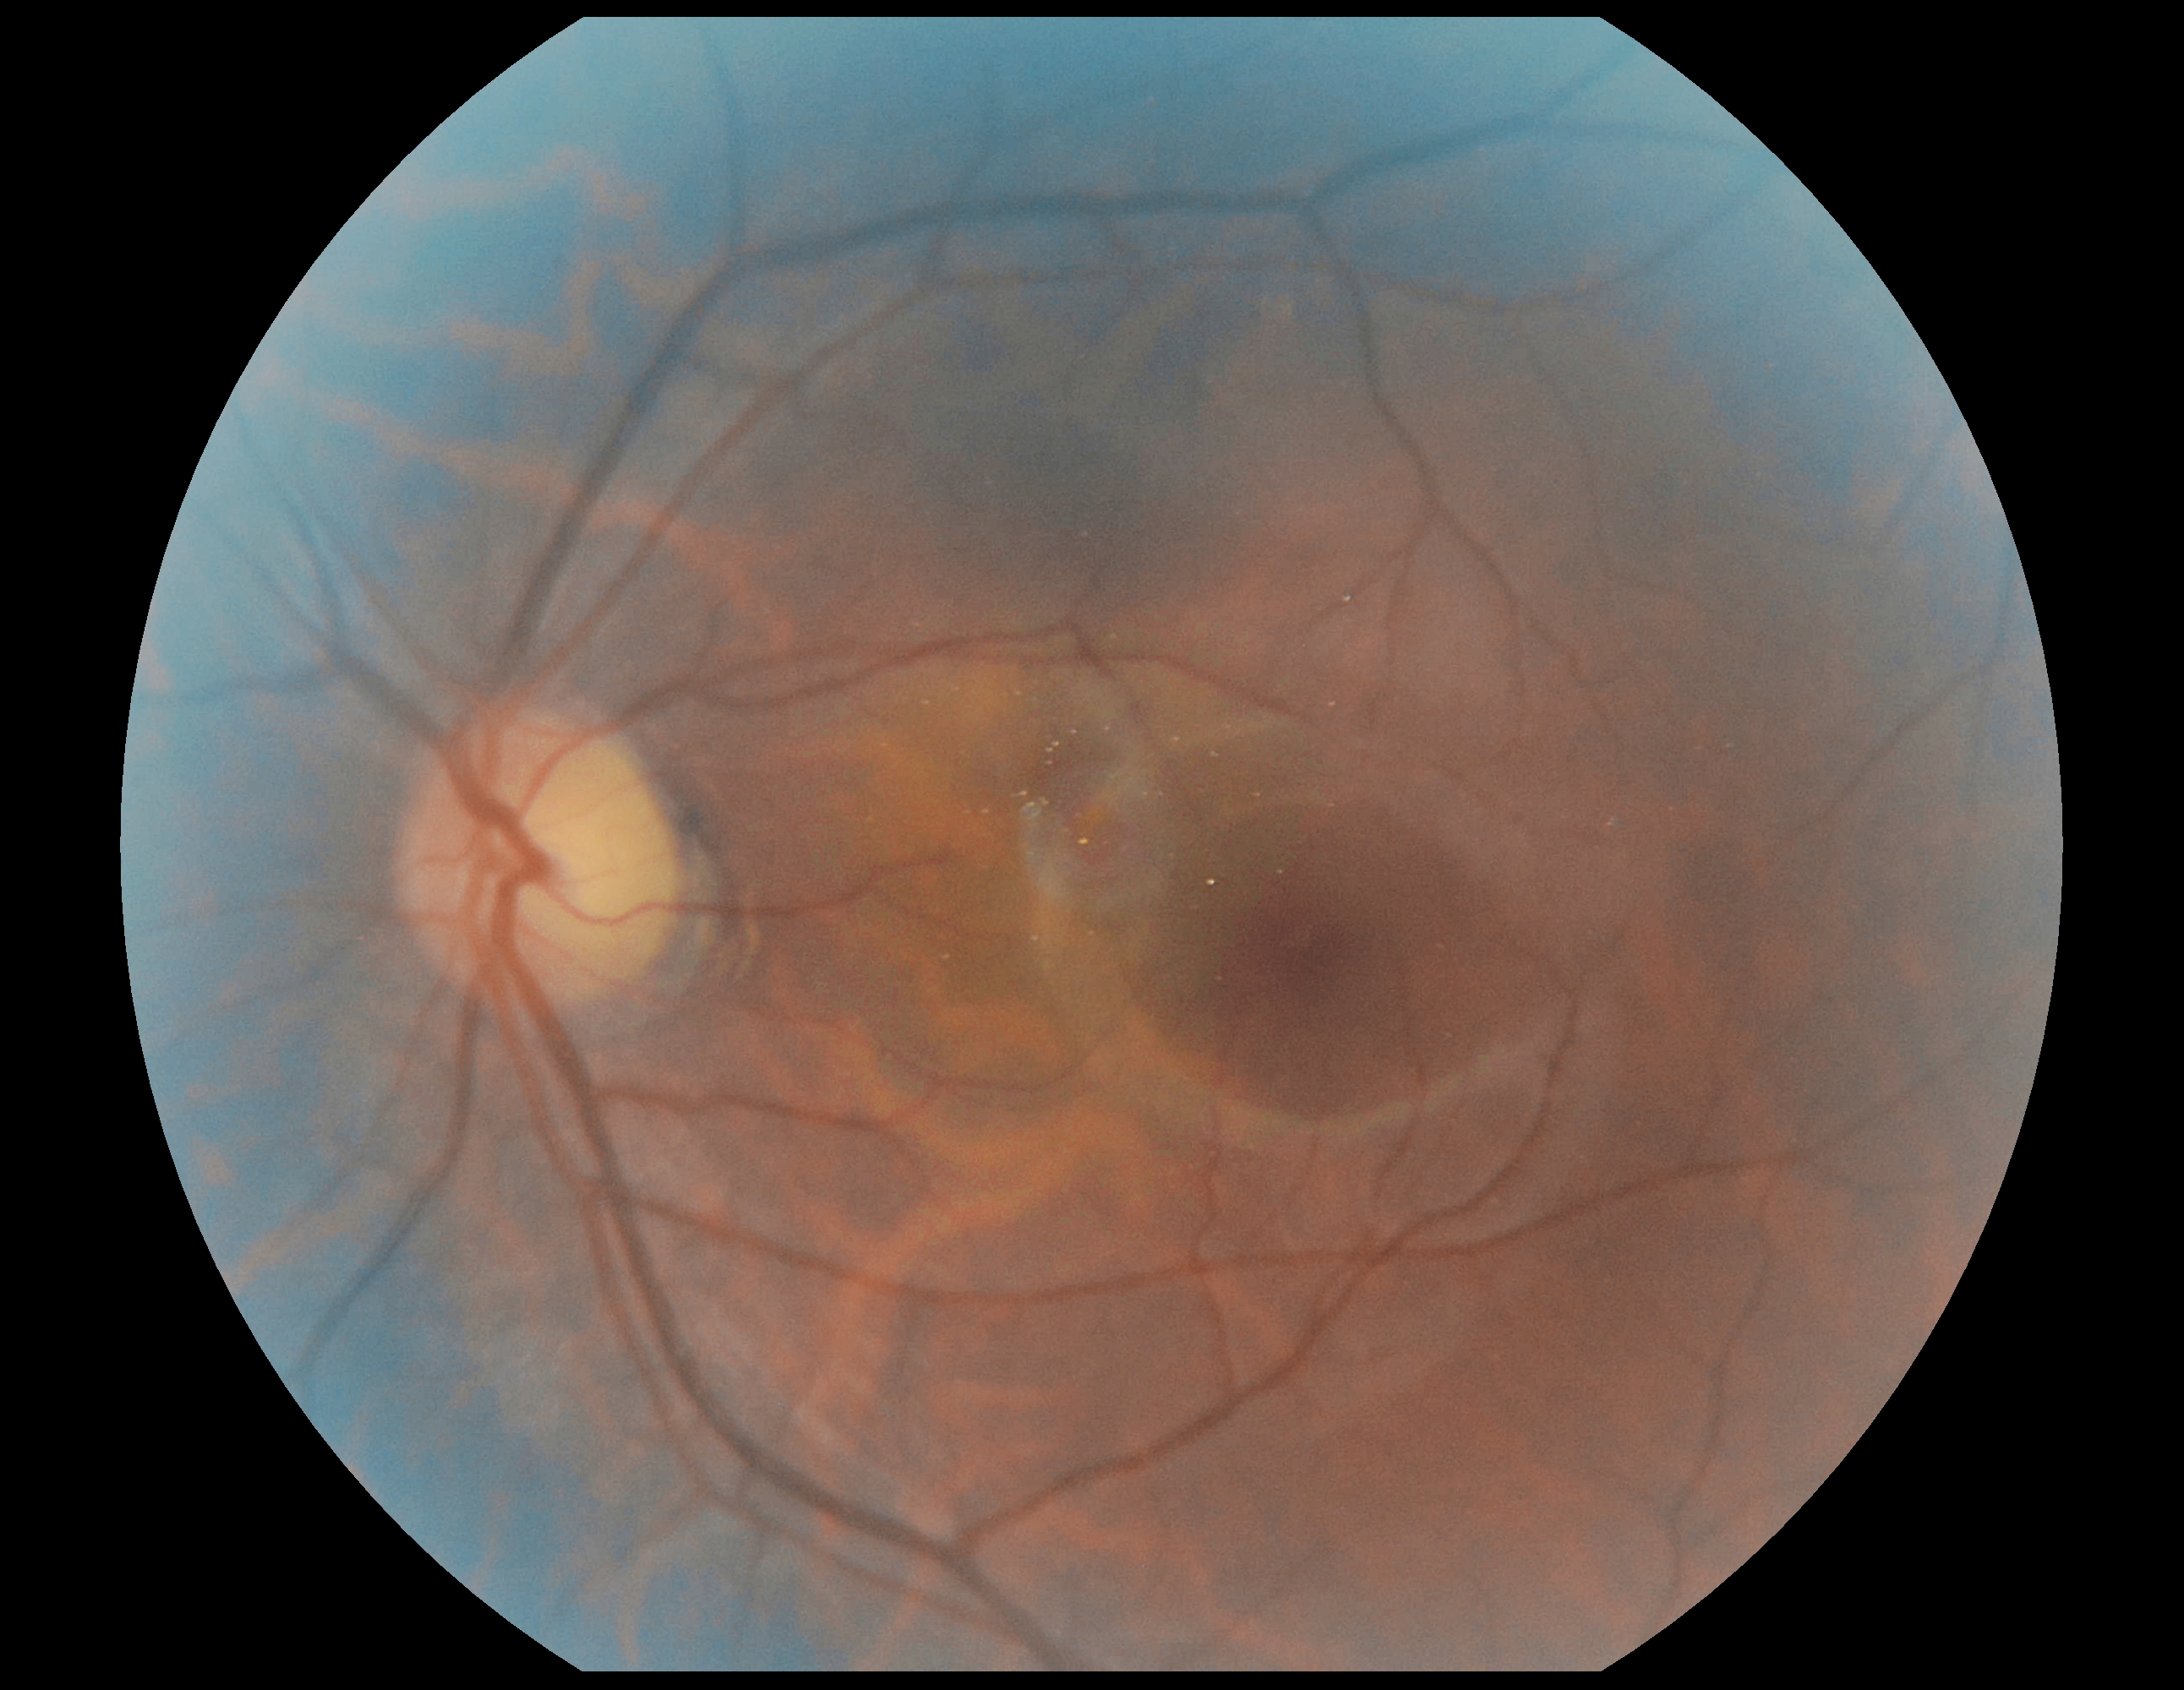 Annotations:
- diabetic retinopathy (DR) — 0/4
- DR impression — no apparent DR